RetCam wide-field infant fundus image; captured with the Clarity RetCam 3 (130° field of view).
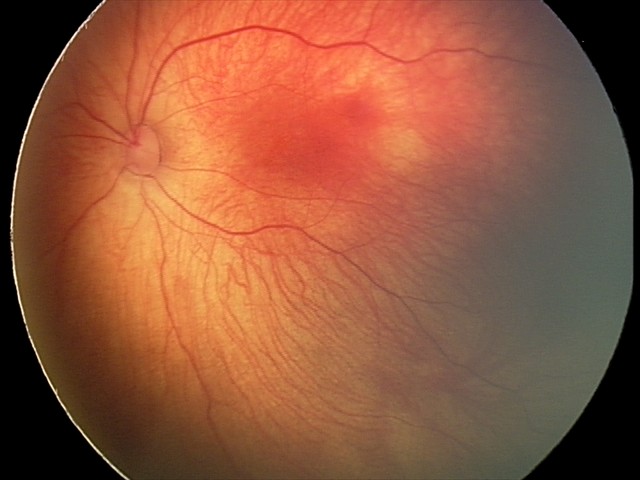
Screening diagnosis: retinal hemorrhages.